Infant wide-field retinal image; 640x480px — 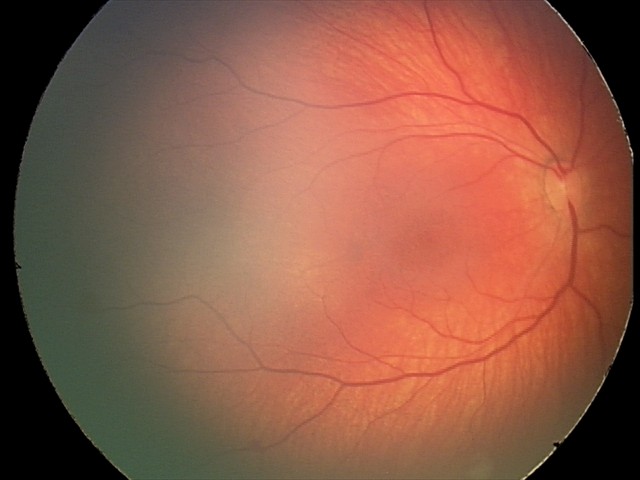 Q: What is the diagnosis from this examination?
A: retinal hemorrhages